45-degree field of view, image size 848x848:
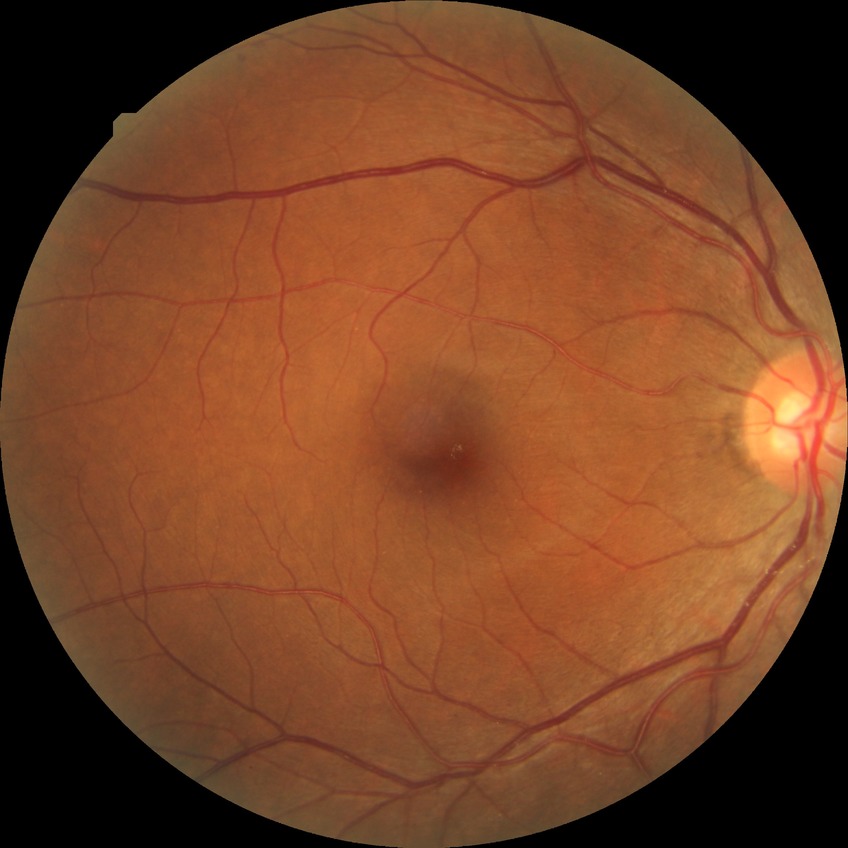

Diabetic retinopathy (DR) is no diabetic retinopathy (NDR).